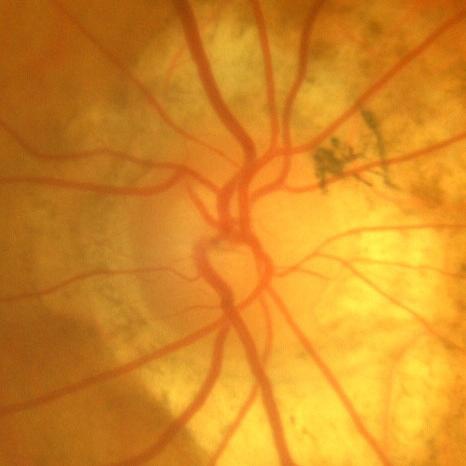

Showing no glaucomatous optic neuropathy.